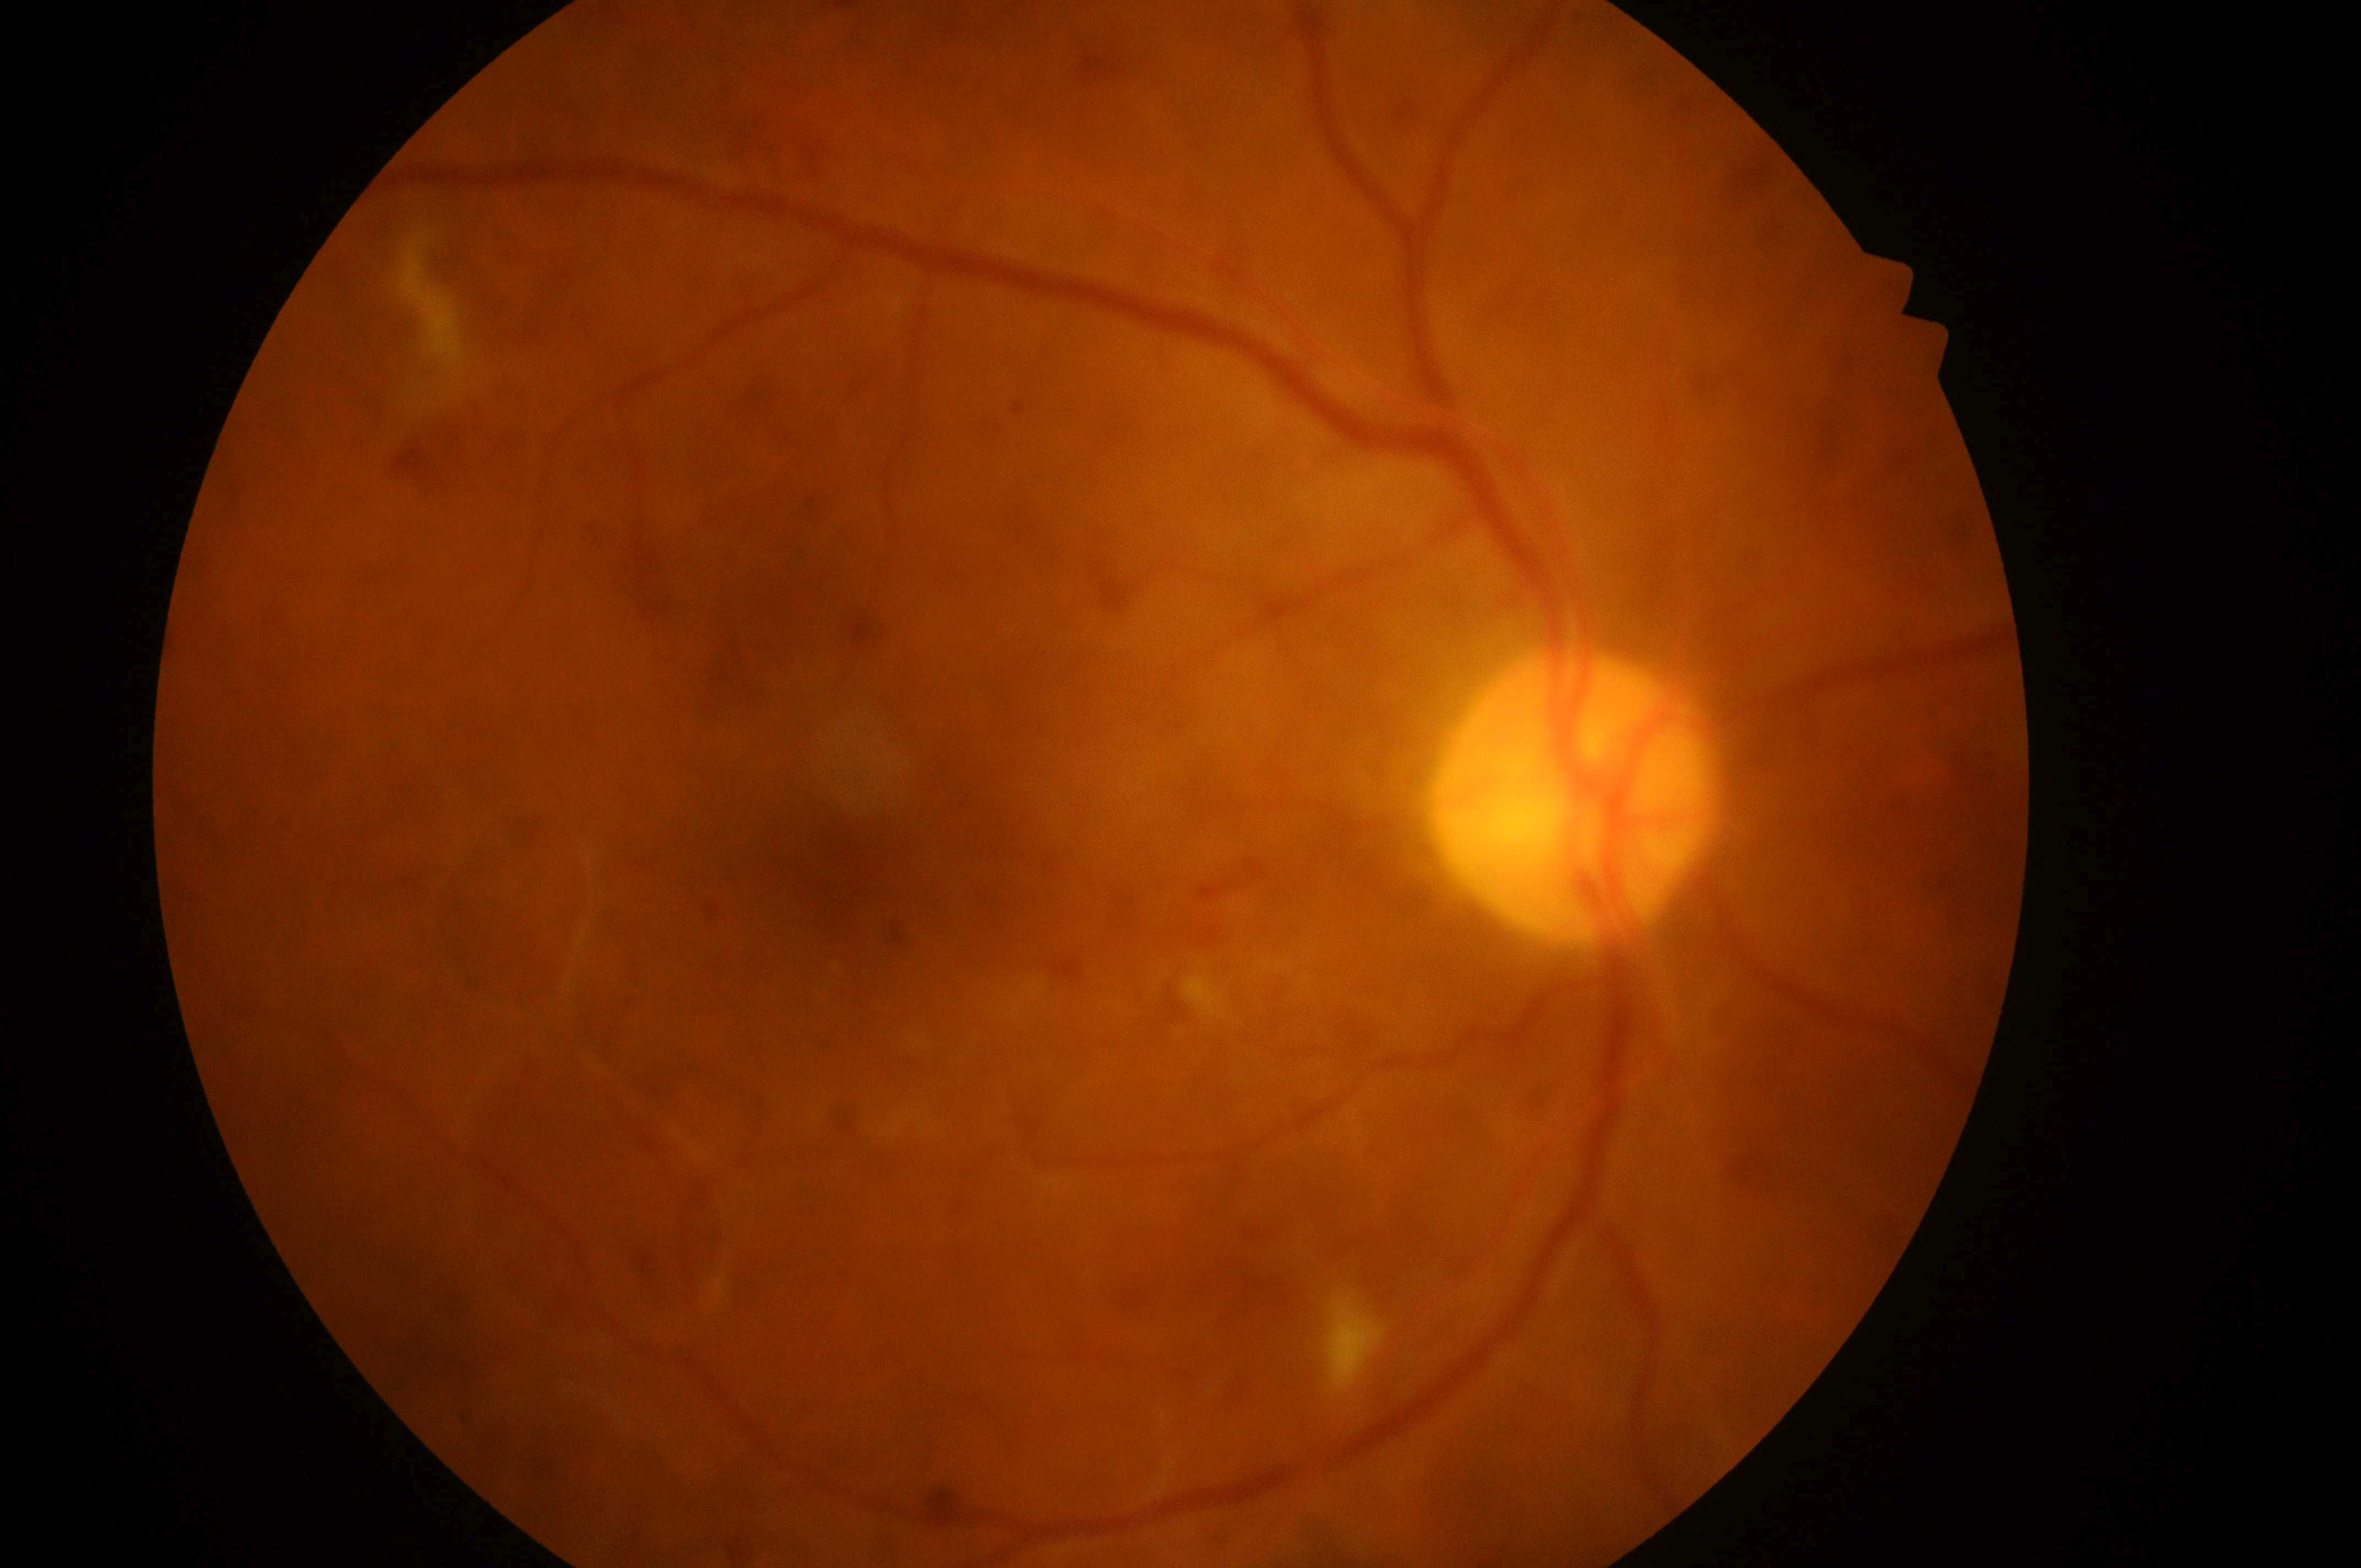
Macular edema is grade 2. The optic disc is at x=1574, y=800. Diabetic retinopathy grade is 4/4. Macula center: x=854, y=876. This is the right eye.